45-degree field of view.
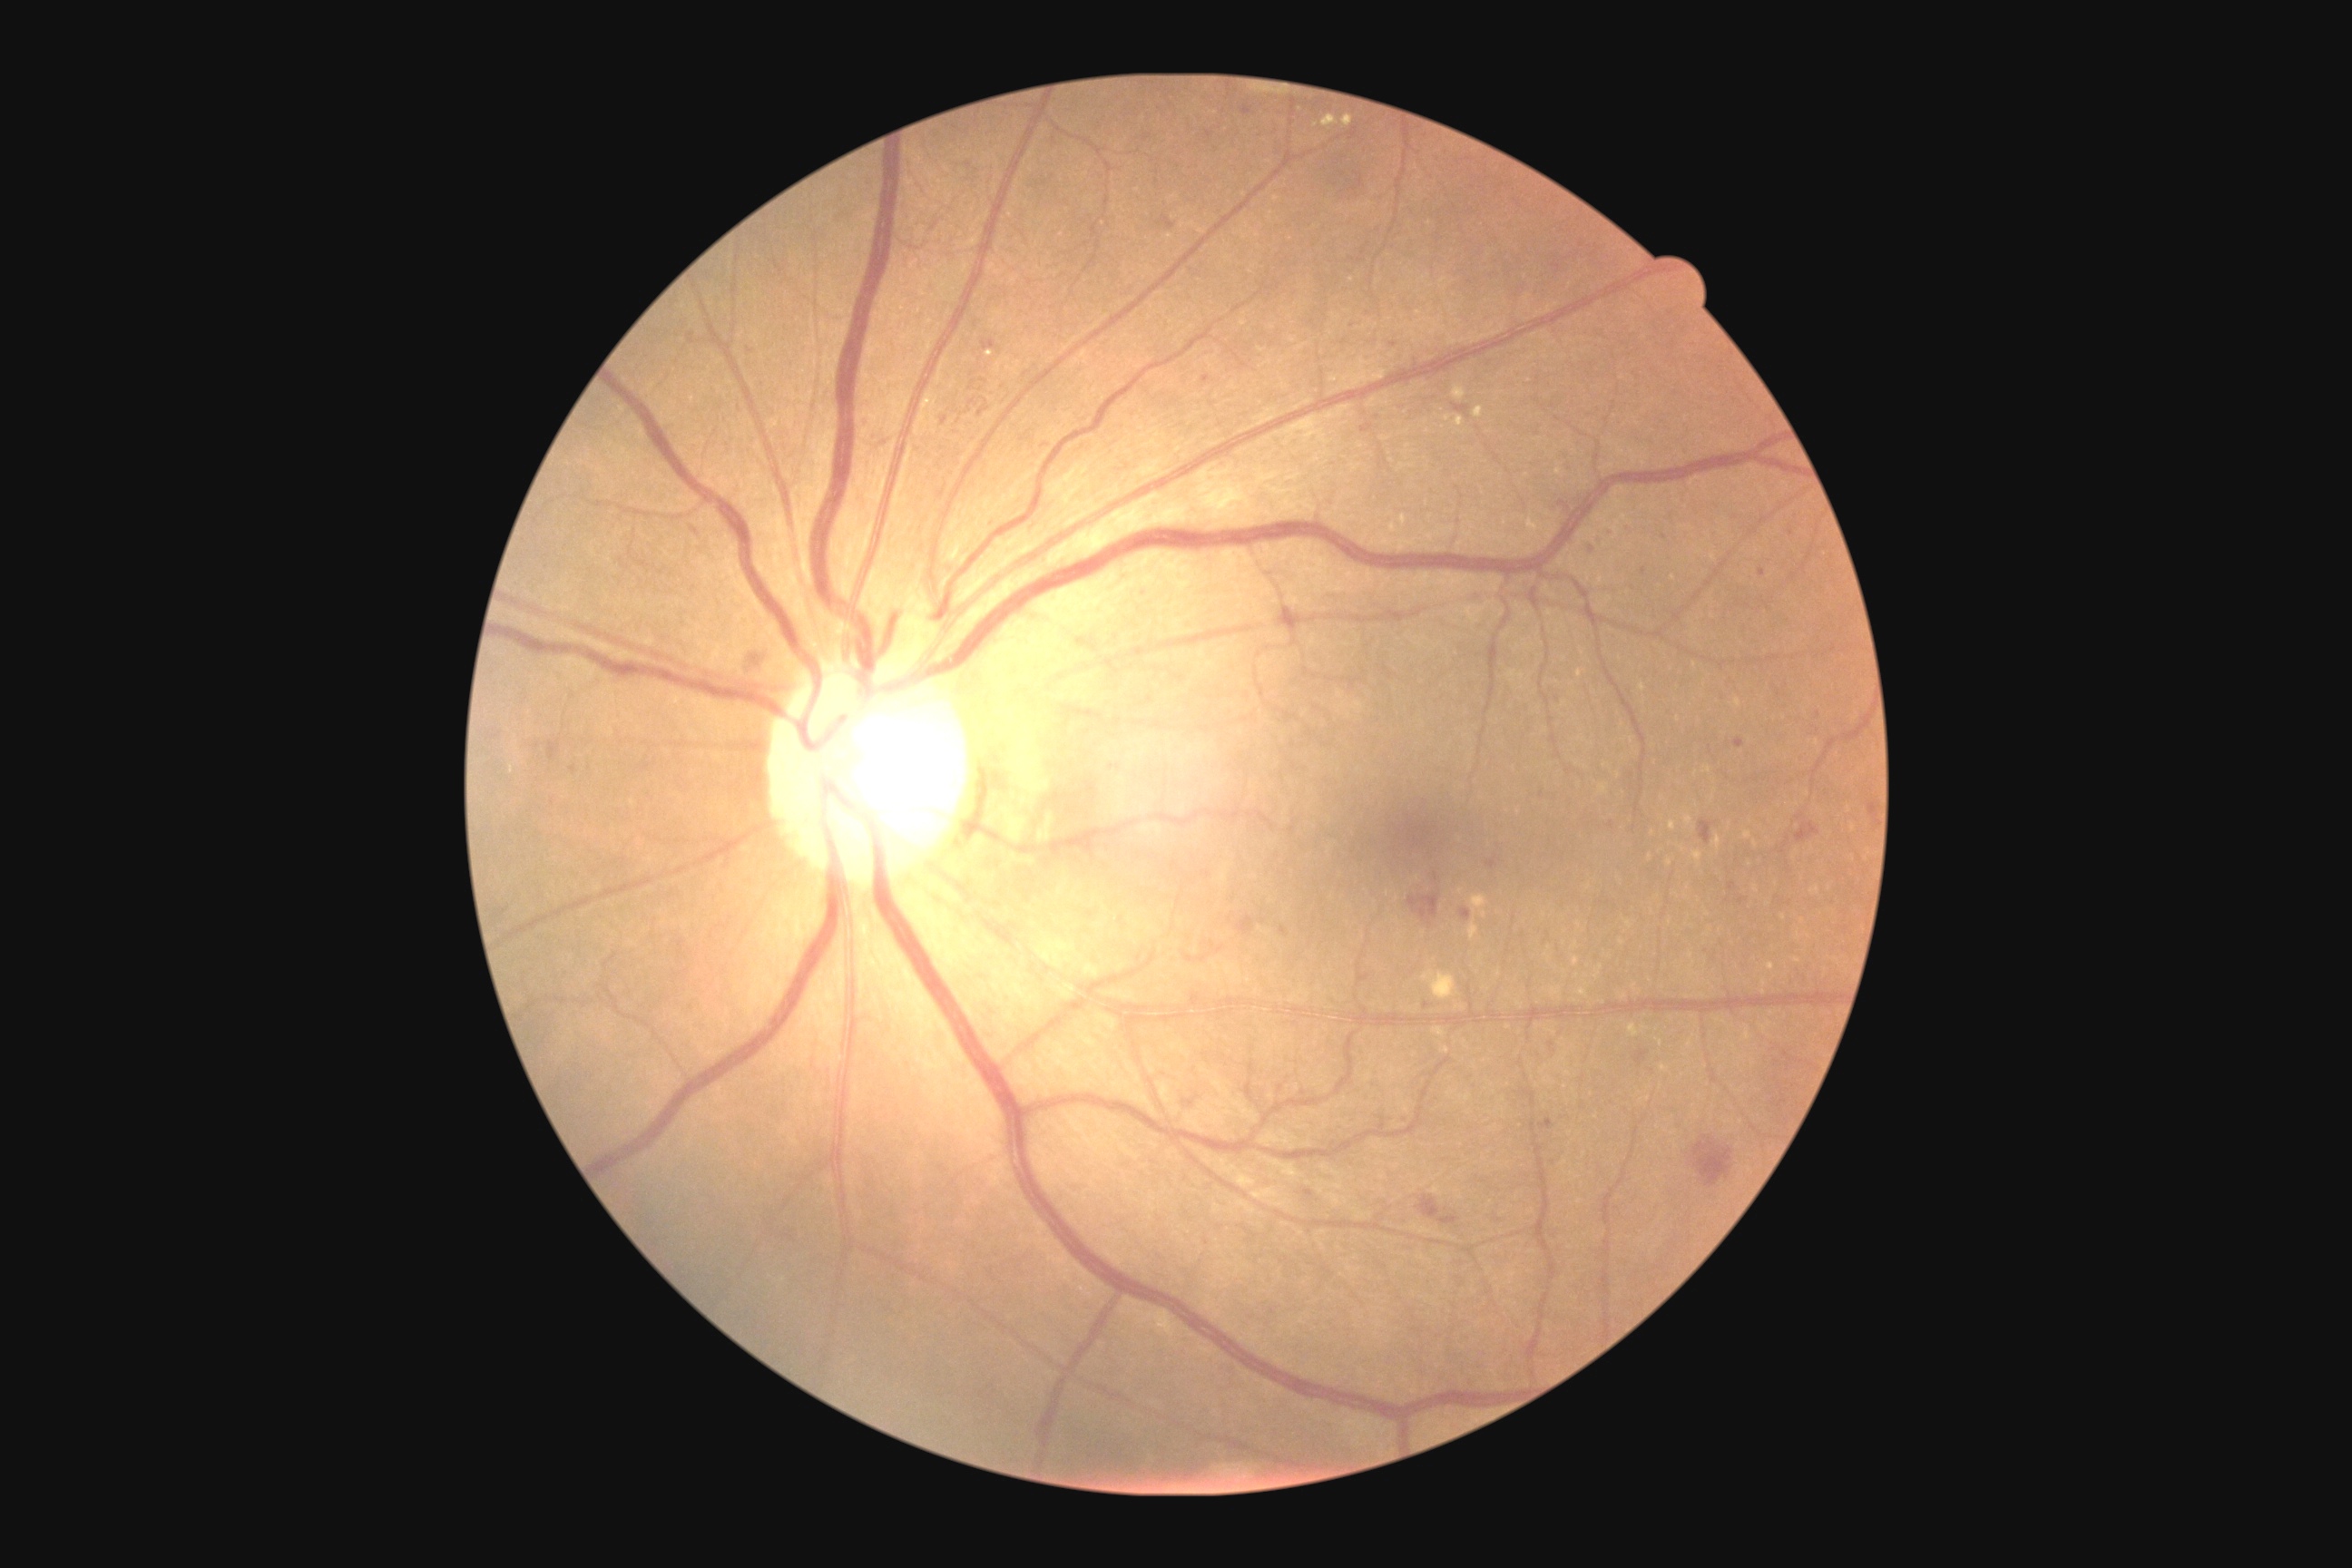

Retinopathy grade: 2 (moderate NPDR); non-proliferative diabetic retinopathy
A subset of detected lesions:
• hemorrhages (continued): BBox(1418, 1197, 1440, 1220), BBox(1694, 1137, 1732, 1186), BBox(1440, 1217, 1458, 1226), BBox(1759, 569, 1767, 578), BBox(1453, 404, 1471, 418), BBox(943, 416, 948, 426), BBox(1242, 106, 1253, 115), BBox(1814, 712, 1823, 721), BBox(1734, 738, 1745, 749), BBox(1560, 502, 1569, 511), BBox(1596, 538, 1603, 547), BBox(1331, 1142, 1337, 1150), BBox(1698, 819, 1712, 845), BBox(1642, 567, 1647, 576), BBox(1540, 1119, 1553, 1130)
• Small hemorrhages near (1426; 1006), (1792; 533), (749; 351), (1313; 322), (1664; 537)
• soft exudates: none detected
• hard exudates: BBox(1453, 384, 1467, 400), BBox(1322, 115, 1338, 128), BBox(986, 351, 994, 358), BBox(1473, 406, 1484, 418), BBox(1400, 514, 1407, 527), BBox(1344, 115, 1355, 128), BBox(1444, 415, 1451, 424), BBox(1455, 416, 1464, 427)
• Small hard exudates near (1315; 126), (1427; 504), (1559; 472), (1431; 518), (1444; 427)
• microaneurysms: none detected